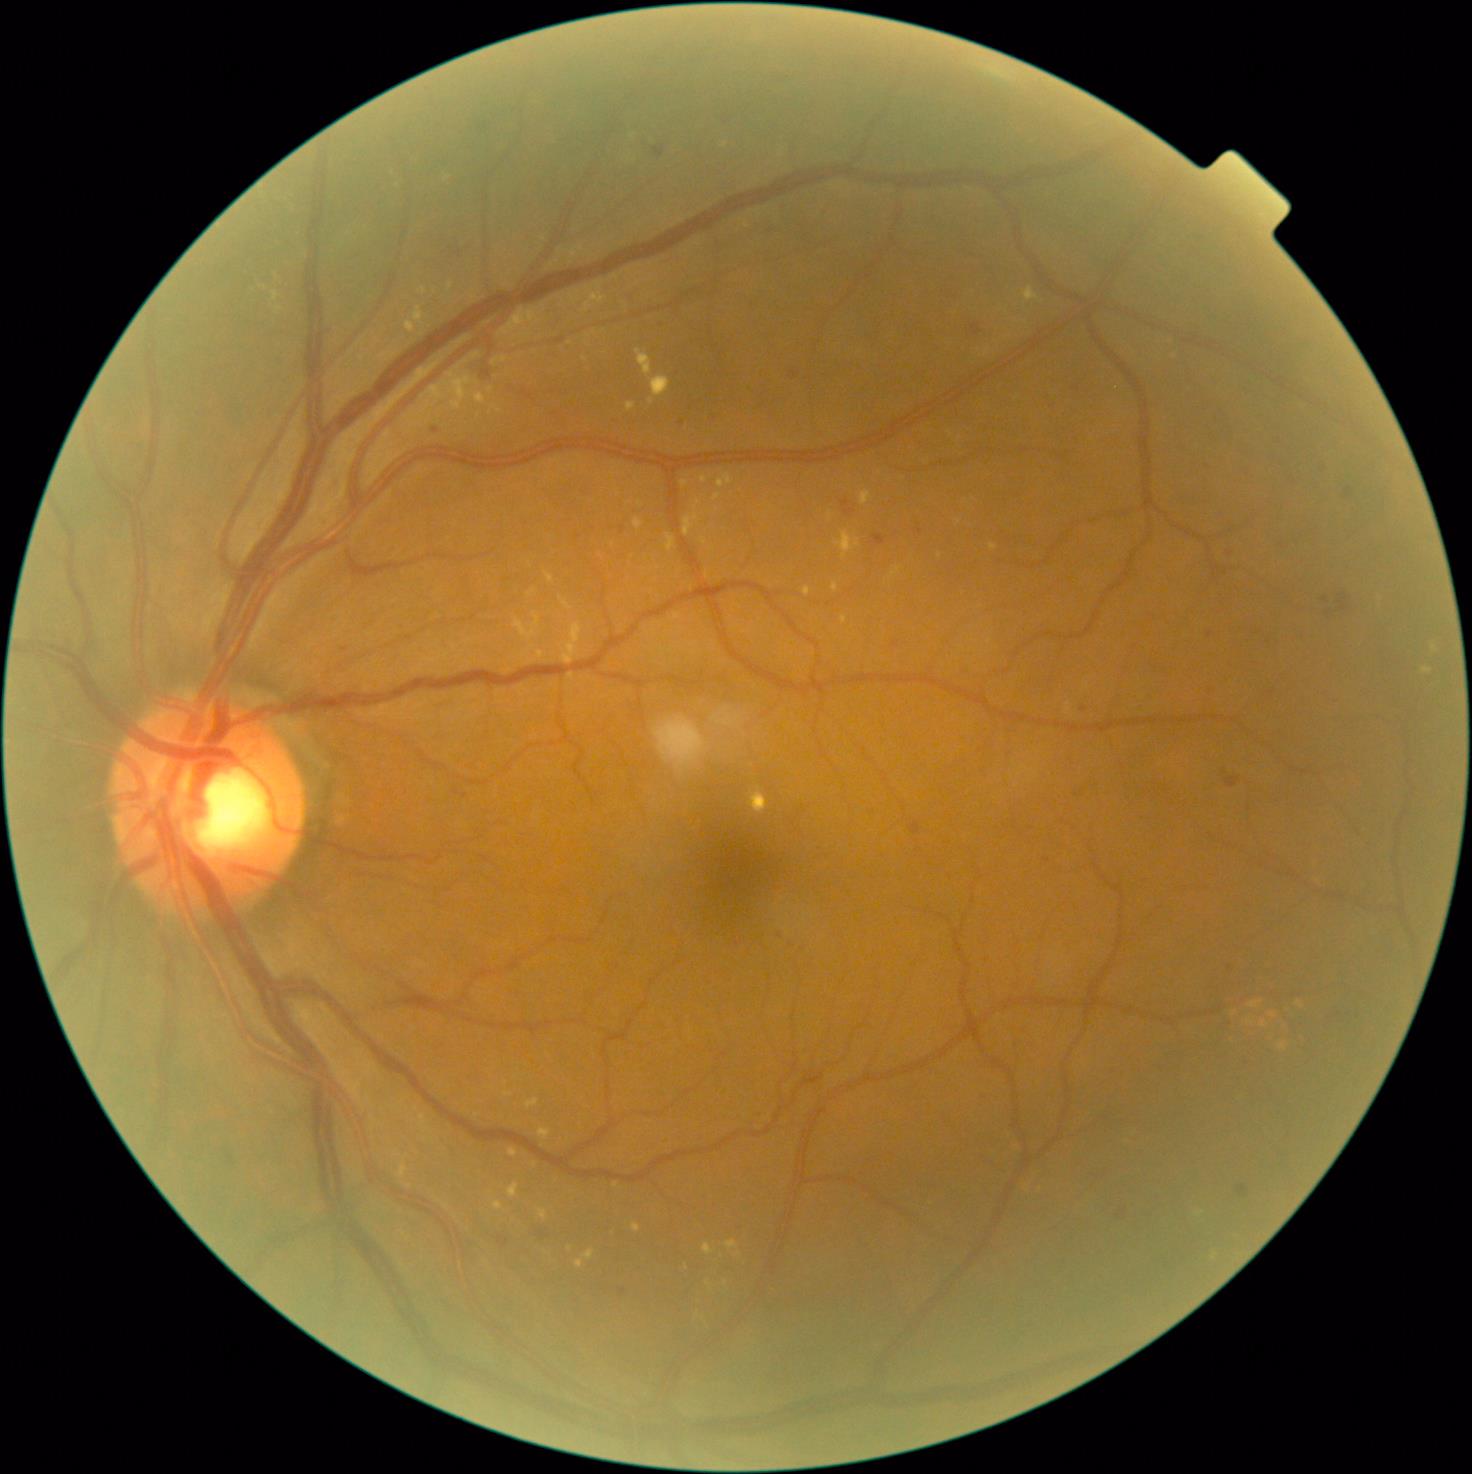

{"partial": true, "dr_grade": 2, "lesions": {"ex": [[526, 1098, 540, 1108], [892, 567, 902, 577], [990, 544, 998, 550], [804, 587, 812, 596], [504, 1092, 513, 1096], [860, 491, 872, 505], [713, 494, 721, 501], [836, 533, 860, 559], [684, 514, 701, 537], [726, 1240, 738, 1250]], "ex_small_approx": [[709, 1283], [726, 1283], [706, 576], [1283, 1046], [989, 642]]}}